2352x1568
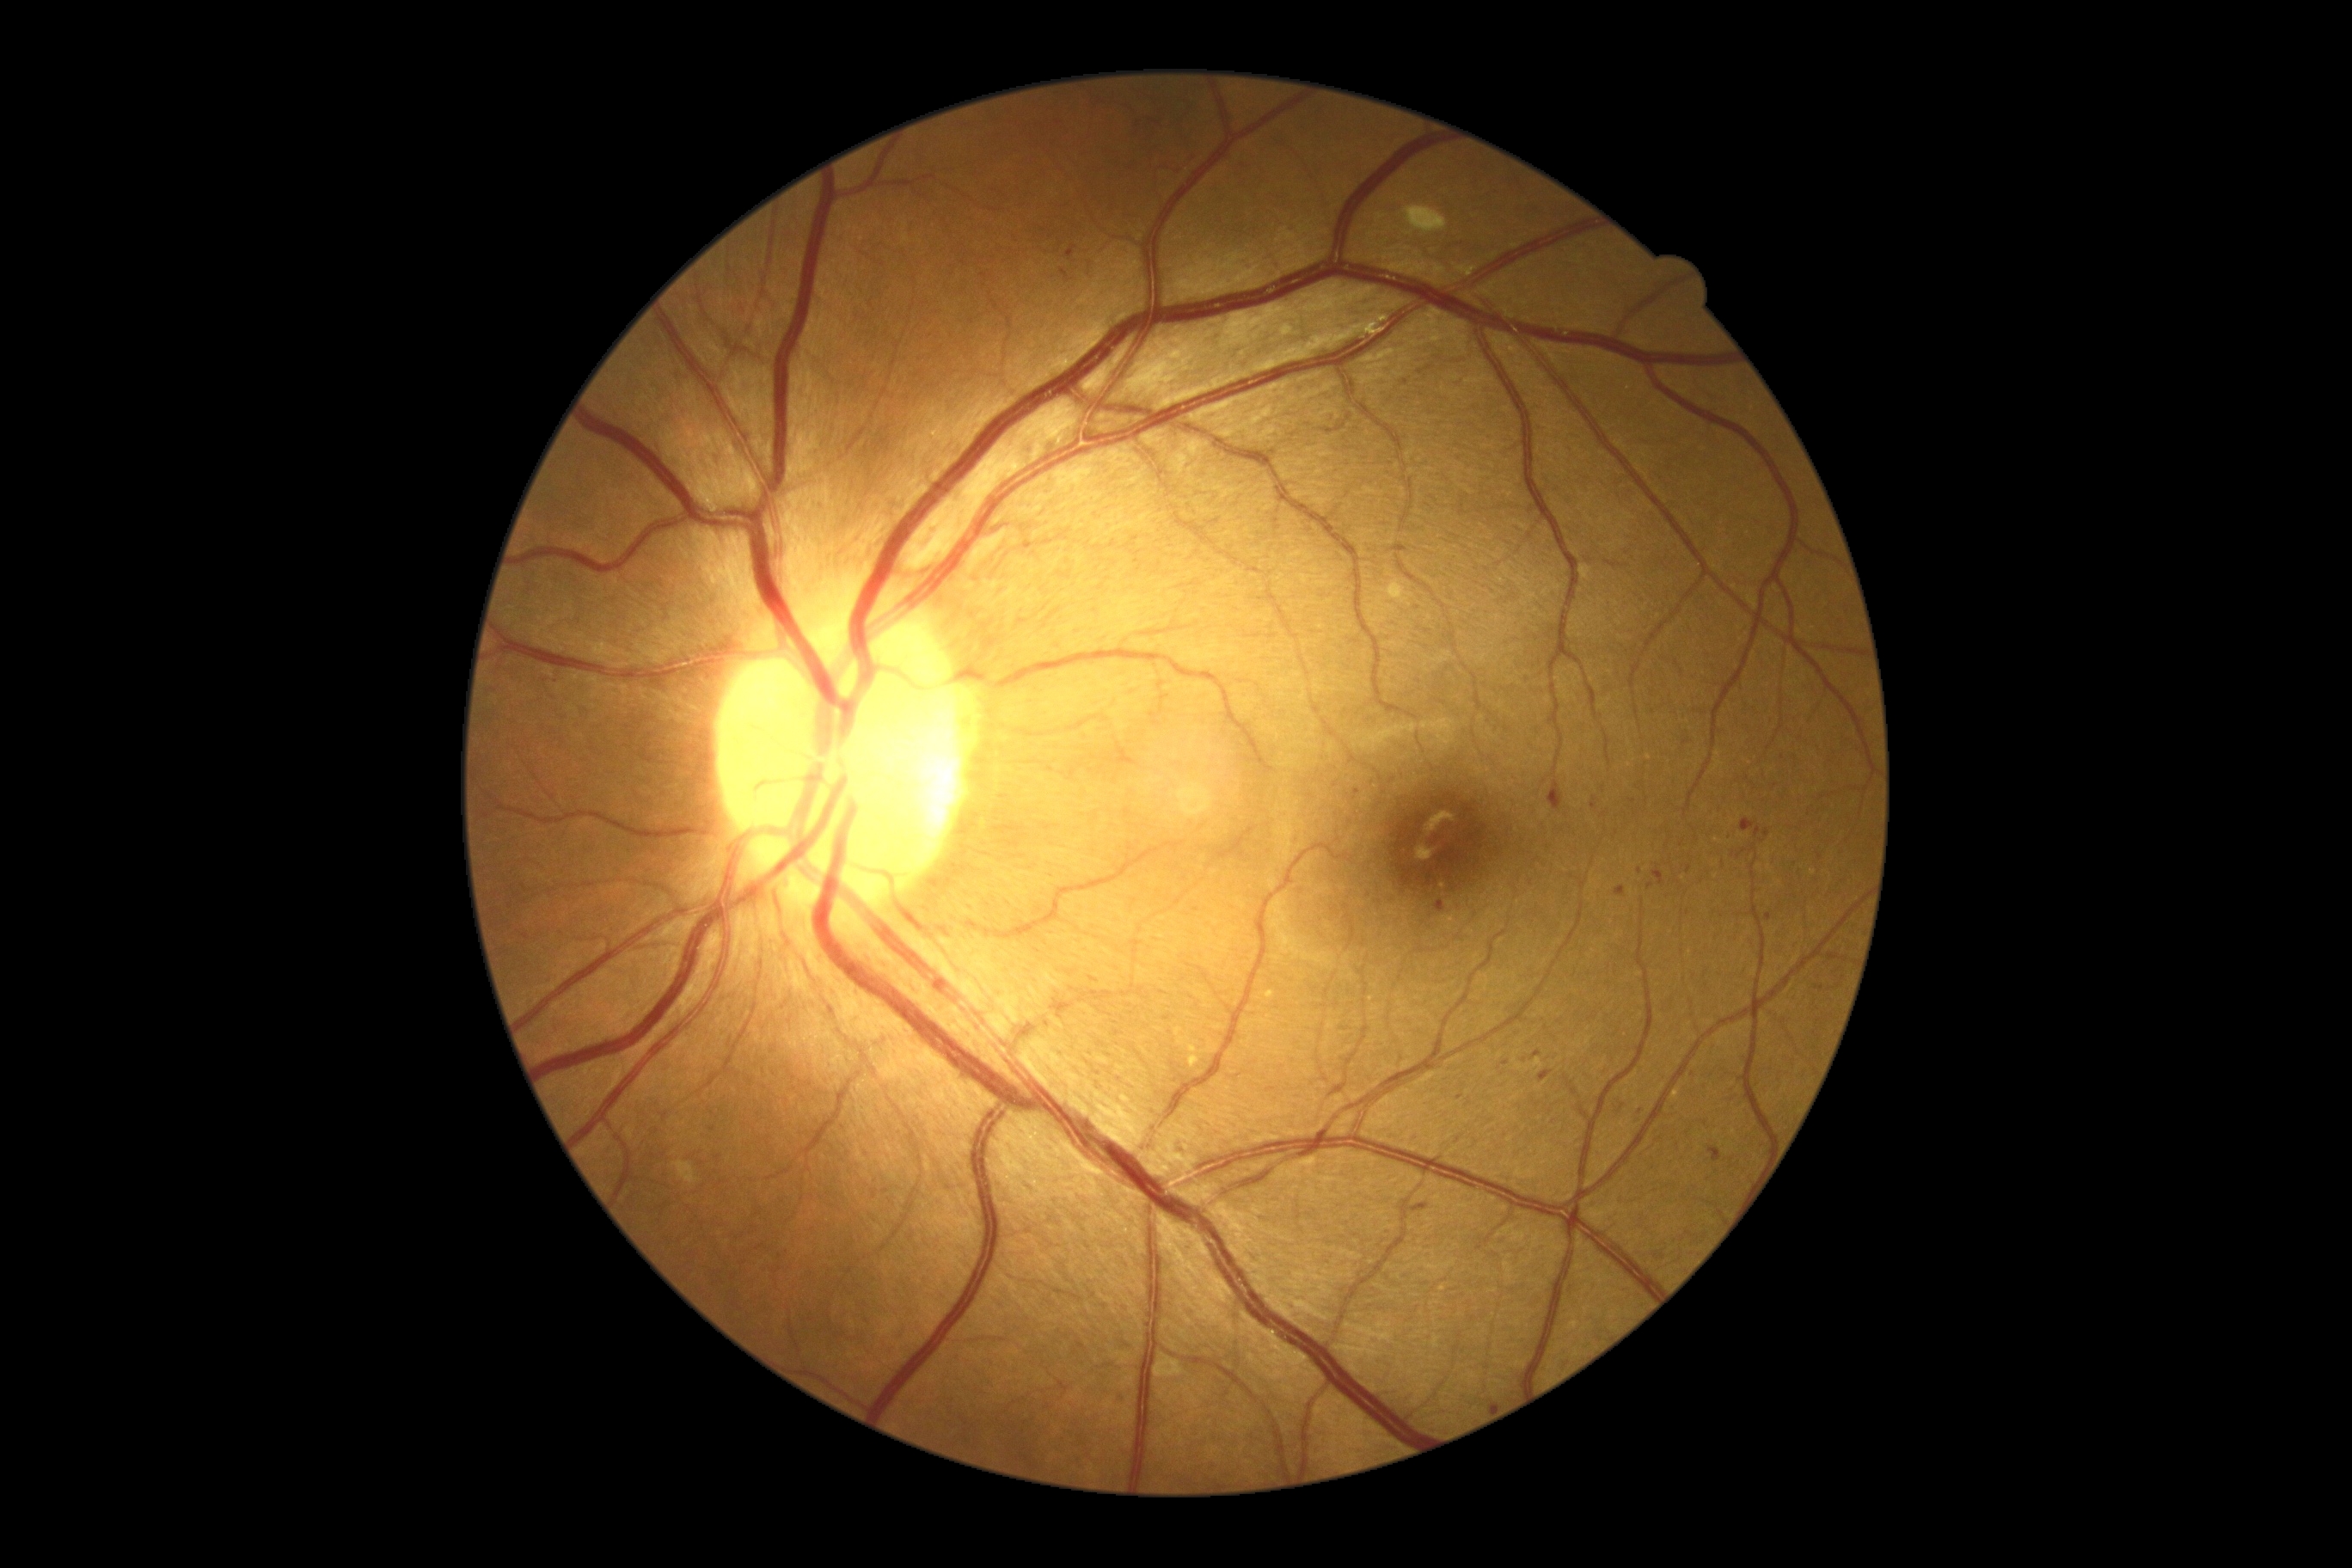
Diabetic retinopathy (DR): grade 2 (moderate NPDR)
Representative lesions:
hemorrhages (HEs) (more not shown) = BBox(1204, 1459, 1220, 1473); BBox(1763, 830, 1770, 838); BBox(1741, 819, 1756, 833); BBox(940, 928, 950, 938); BBox(1755, 828, 1761, 838); BBox(1612, 1094, 1629, 1118); BBox(1435, 900, 1447, 914); BBox(1502, 1062, 1510, 1067); BBox(1854, 881, 1865, 890); BBox(1700, 1081, 1708, 1093); BBox(1057, 264, 1070, 283)
Small HEs near (1640; 871); (1493; 1406); (1459; 1097); (1820; 857); (1692; 1075)